Davis DR grading — 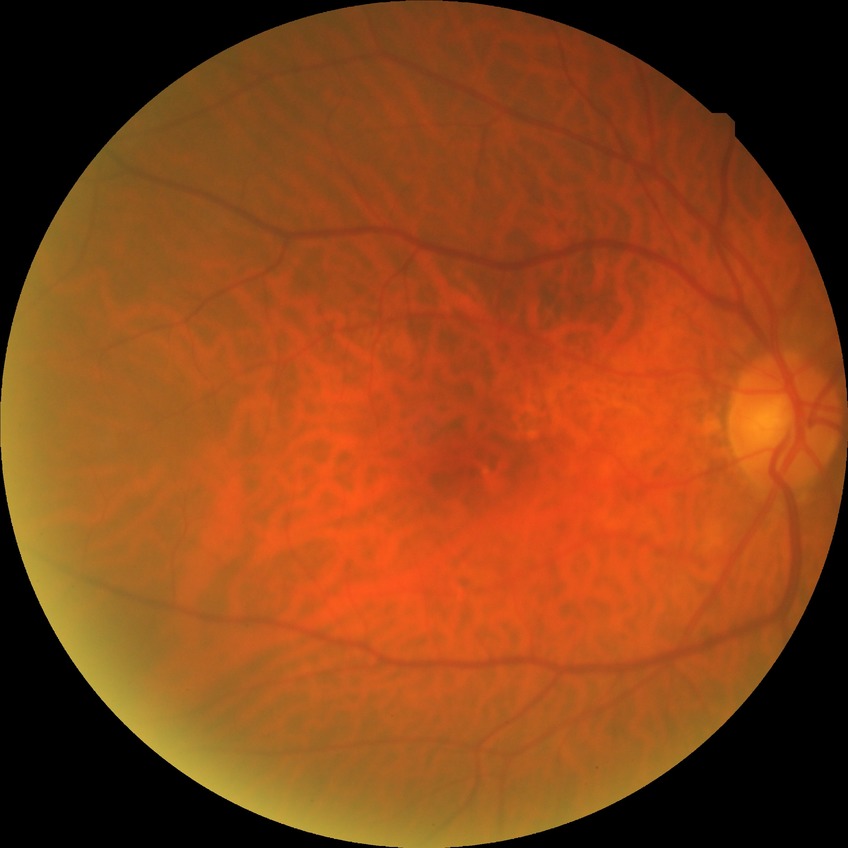 Diabetic retinopathy (DR): no diabetic retinopathy (NDR).